100° field of view (Phoenix ICON); pediatric retinal photograph (wide-field): 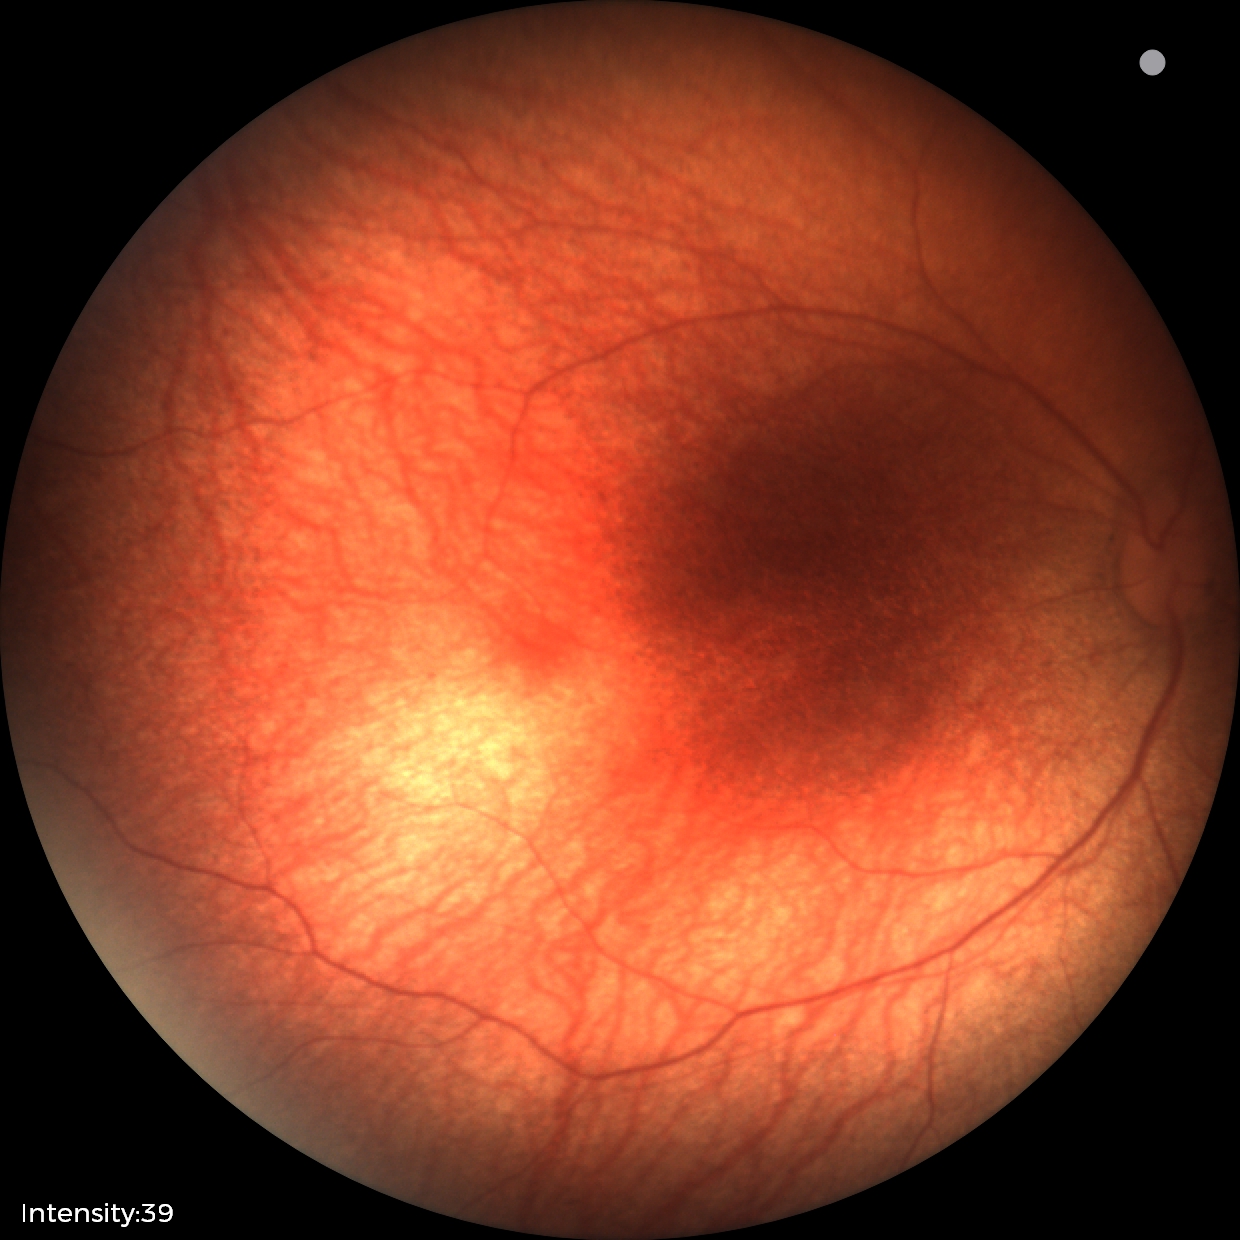 Examination with physiological retinal findings.